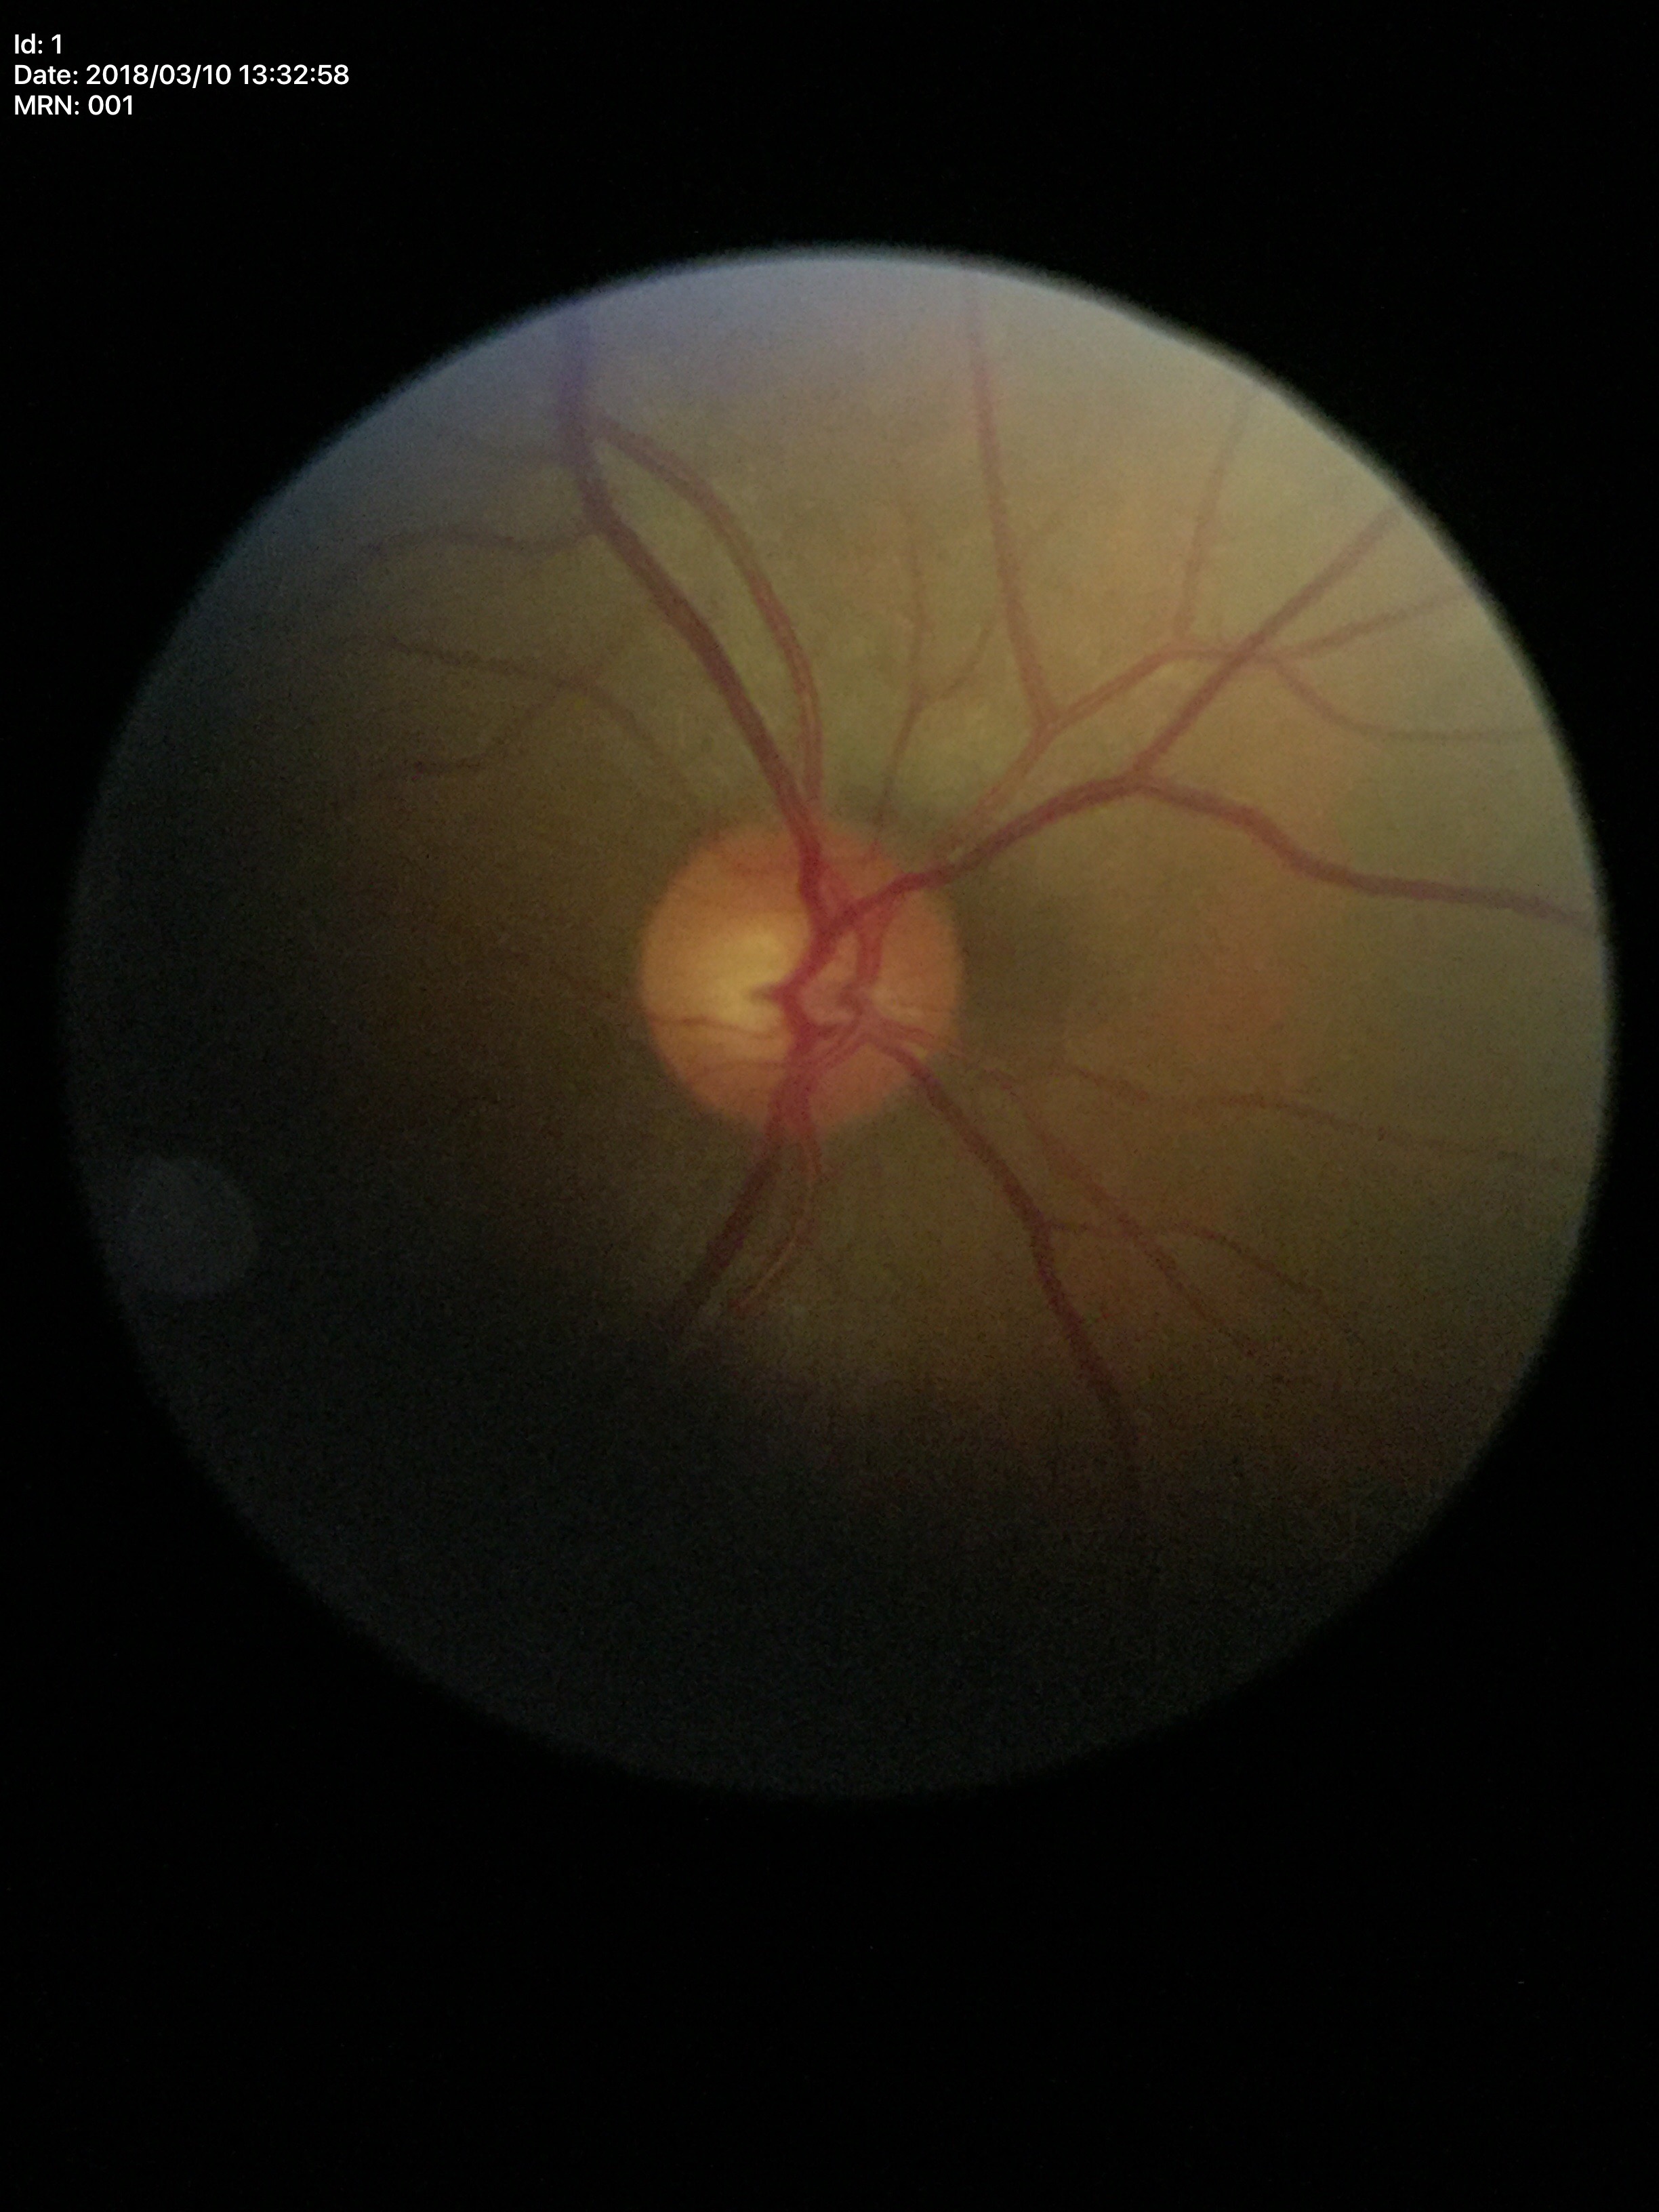 No signs of glaucoma.
Vertical CDR (VCDR): 0.54.
Horizontal cup-to-disc ratio (HCDR): 0.58.